Acquired with a Remidio smartphone fundus camera; 1659x2212px; color fundus photograph: 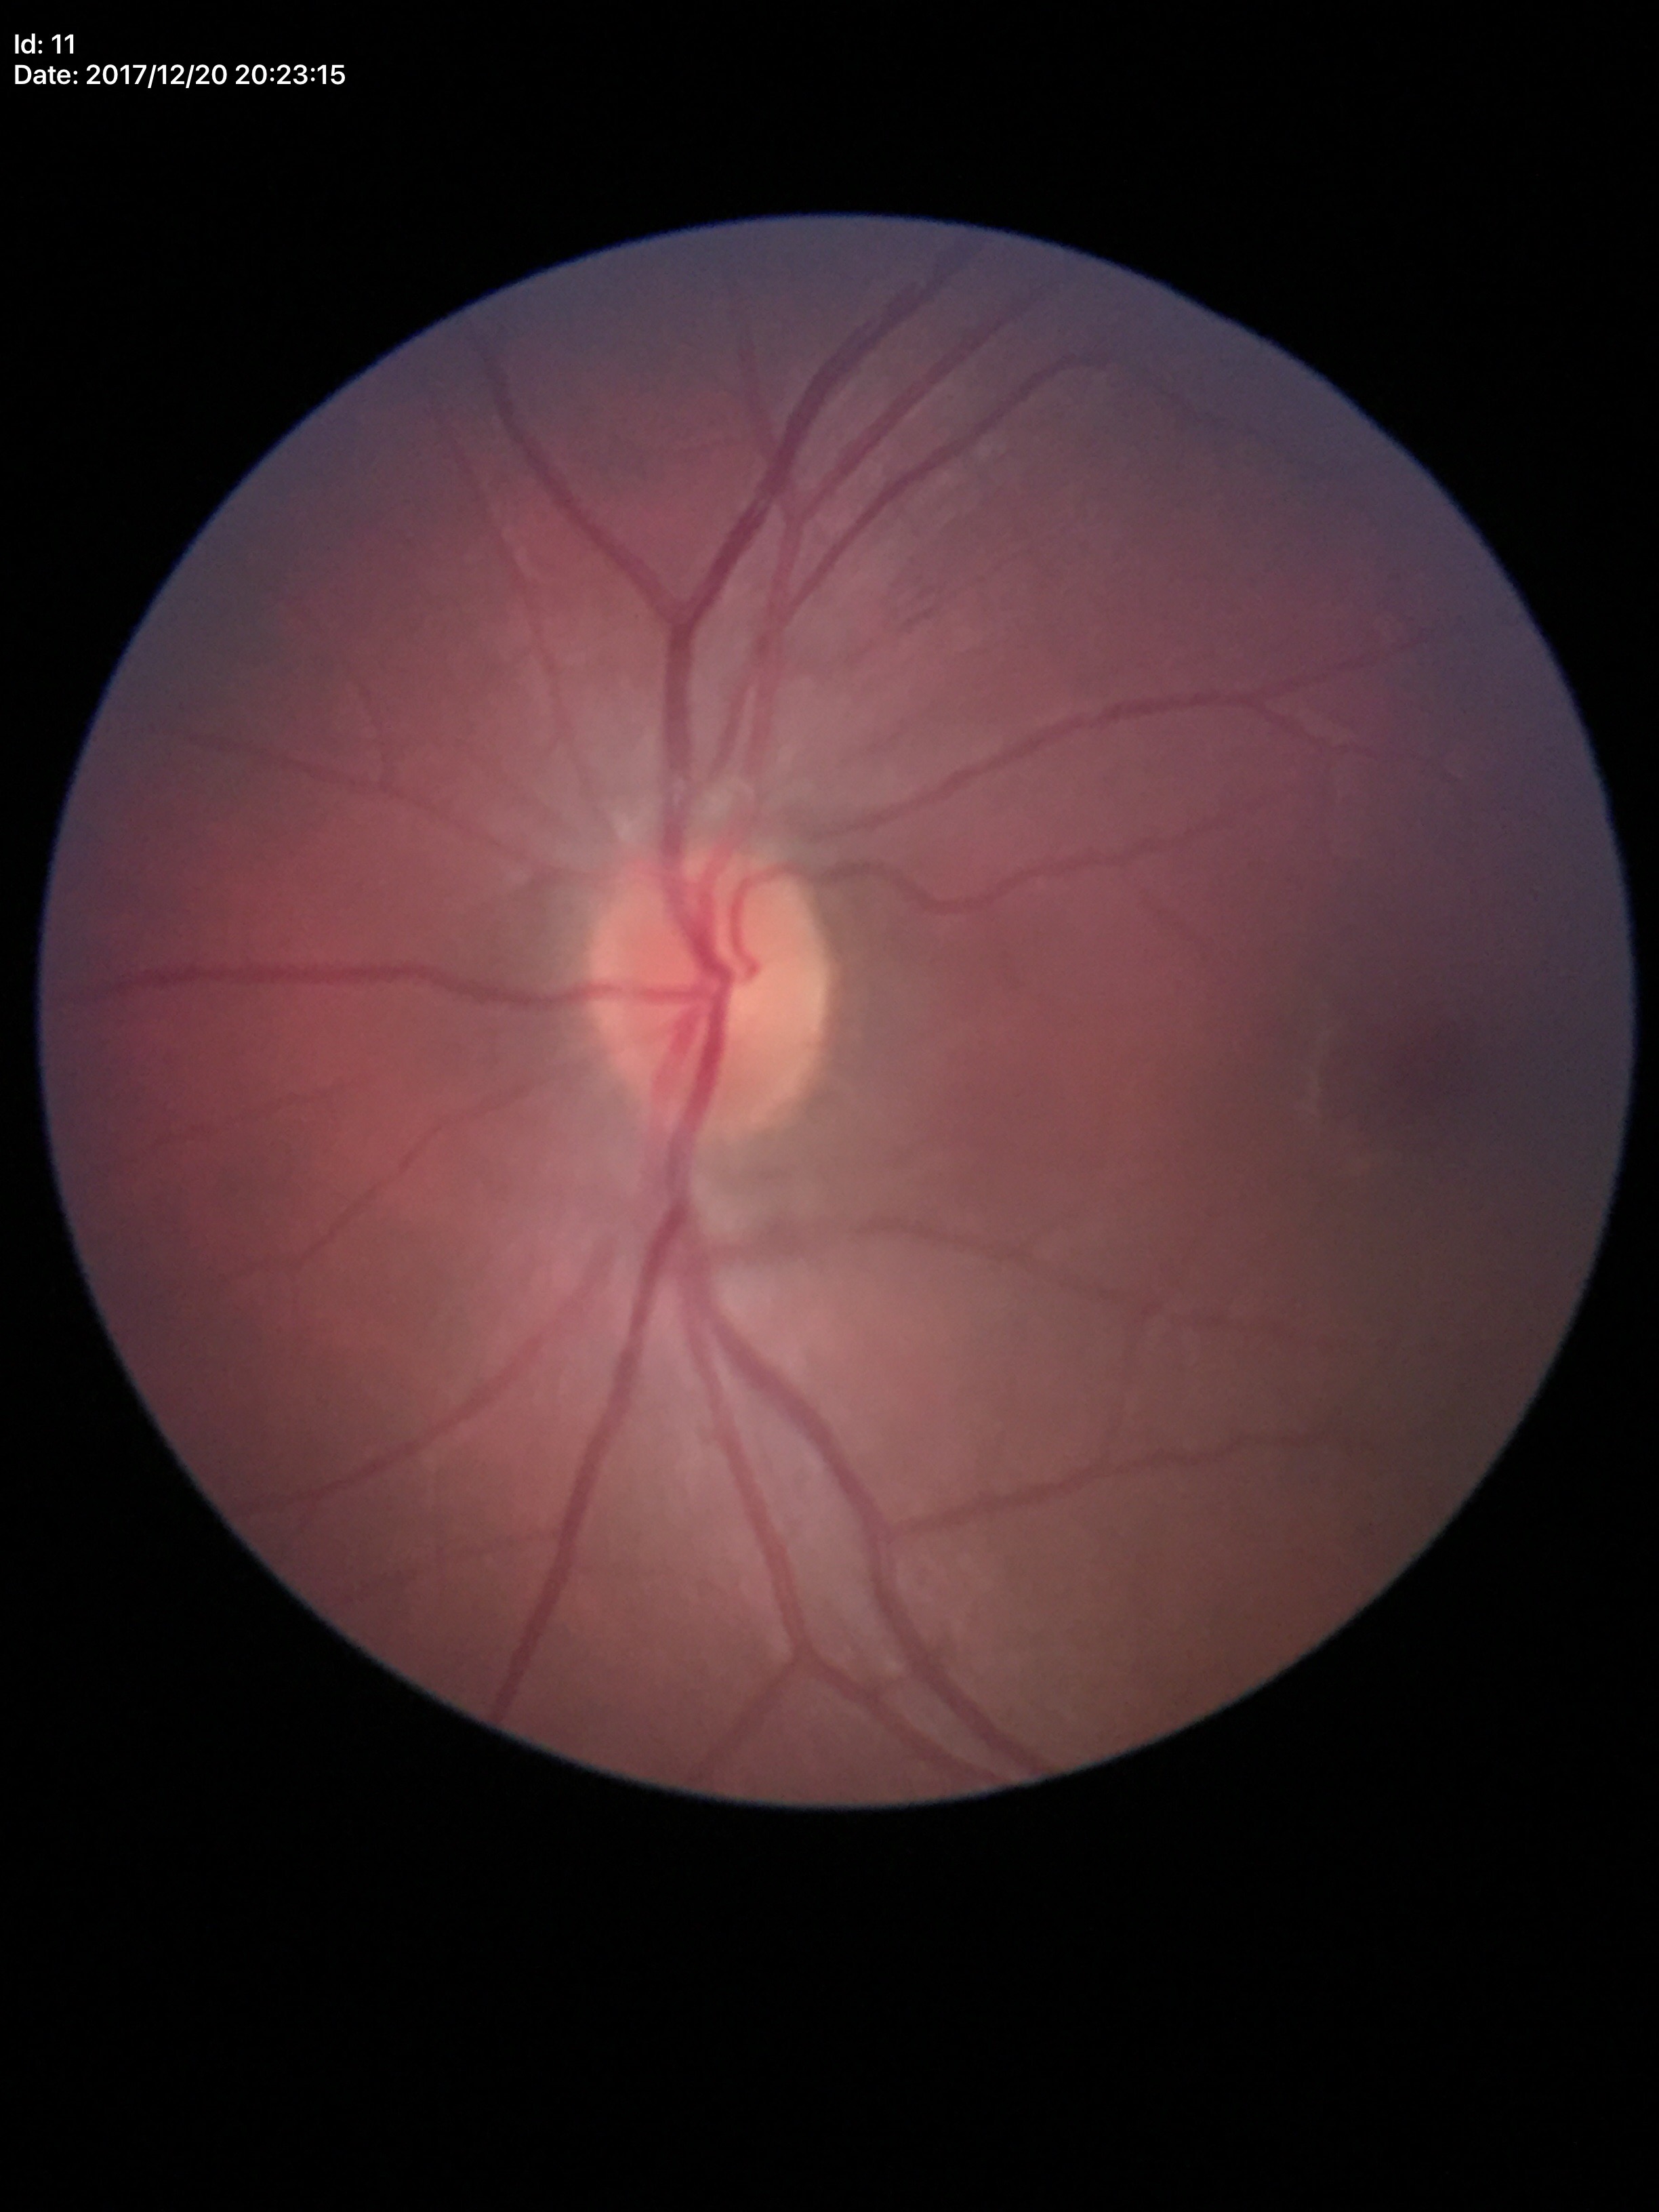 Glaucoma evaluation: not suspect.
Area C/D ratio: 0.20.
Vertical cup-disc ratio is 0.43.